640x480 · RetCam wide-field infant fundus image · camera: Clarity RetCam 3 (130° FOV)
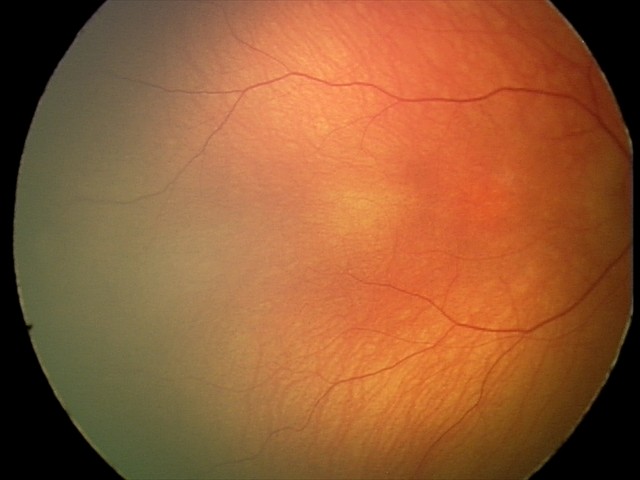 Screening diagnosis: physiological appearance.